Optic disc photograph:
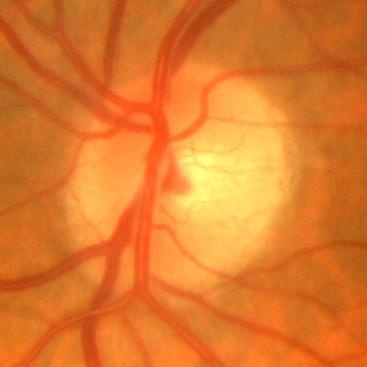 Showing no evidence of glaucoma.